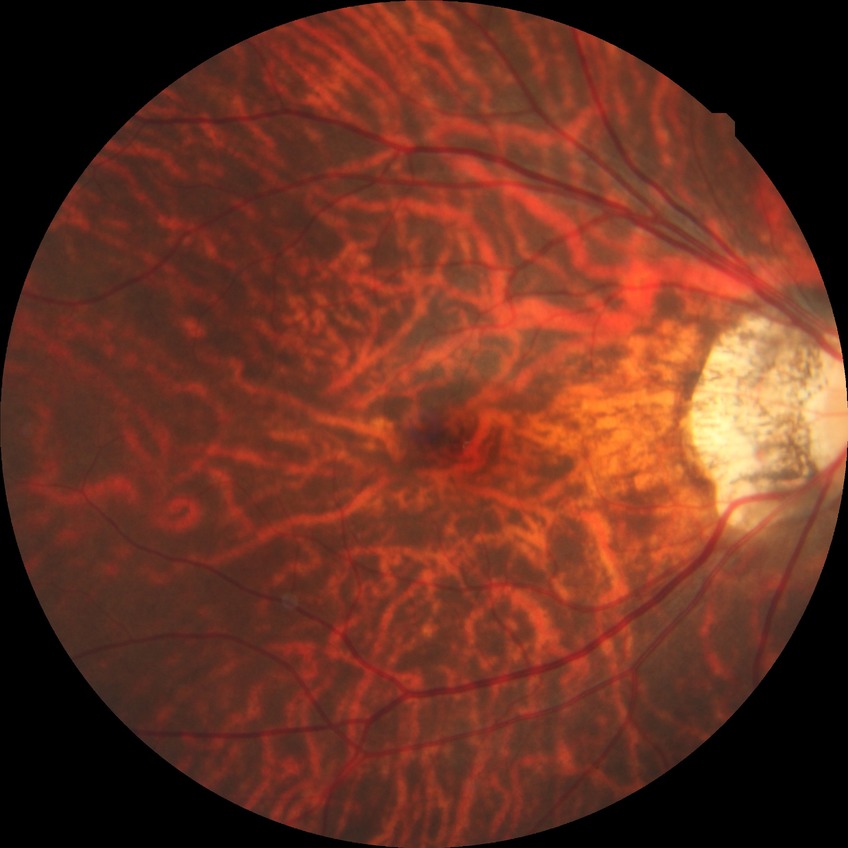 {
  "davis_grade": "no diabetic retinopathy"
}